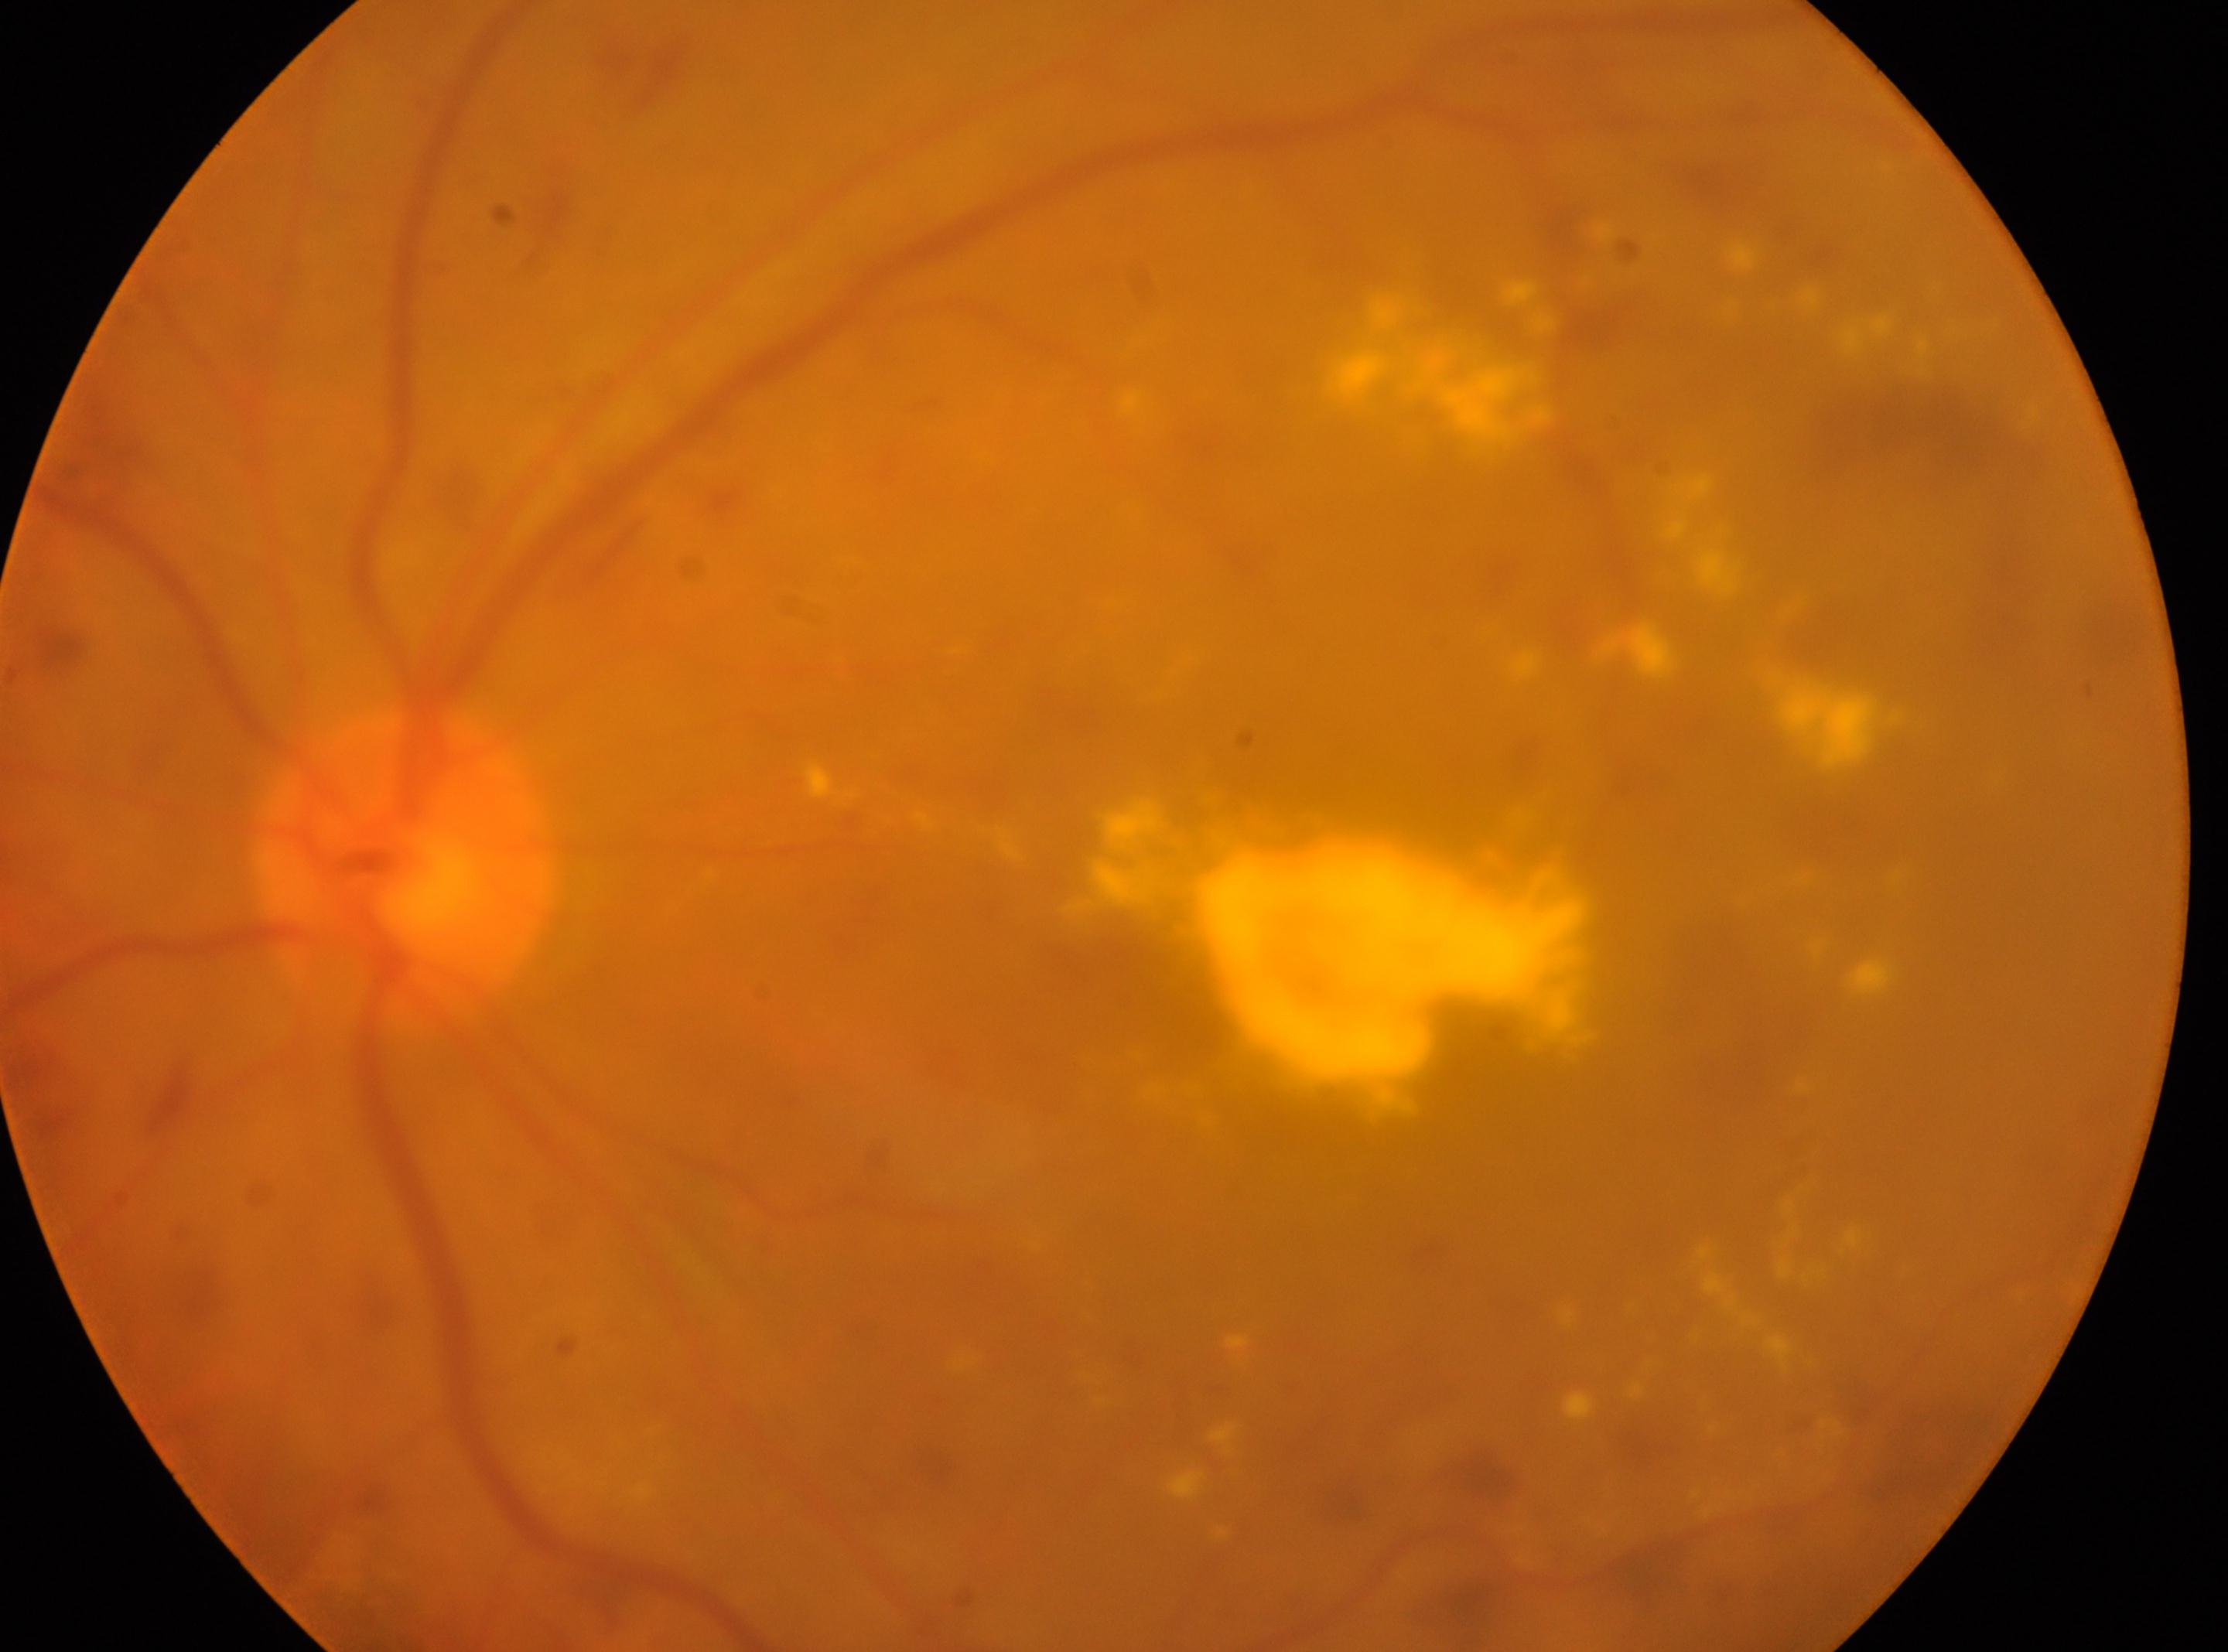

* ONH: (x=404, y=872)
* laterality: oculus sinister
* DR severity: 3/4
* fovea: (x=1157, y=987)